Camera: Topcon TRC · optic nerve head photograph:
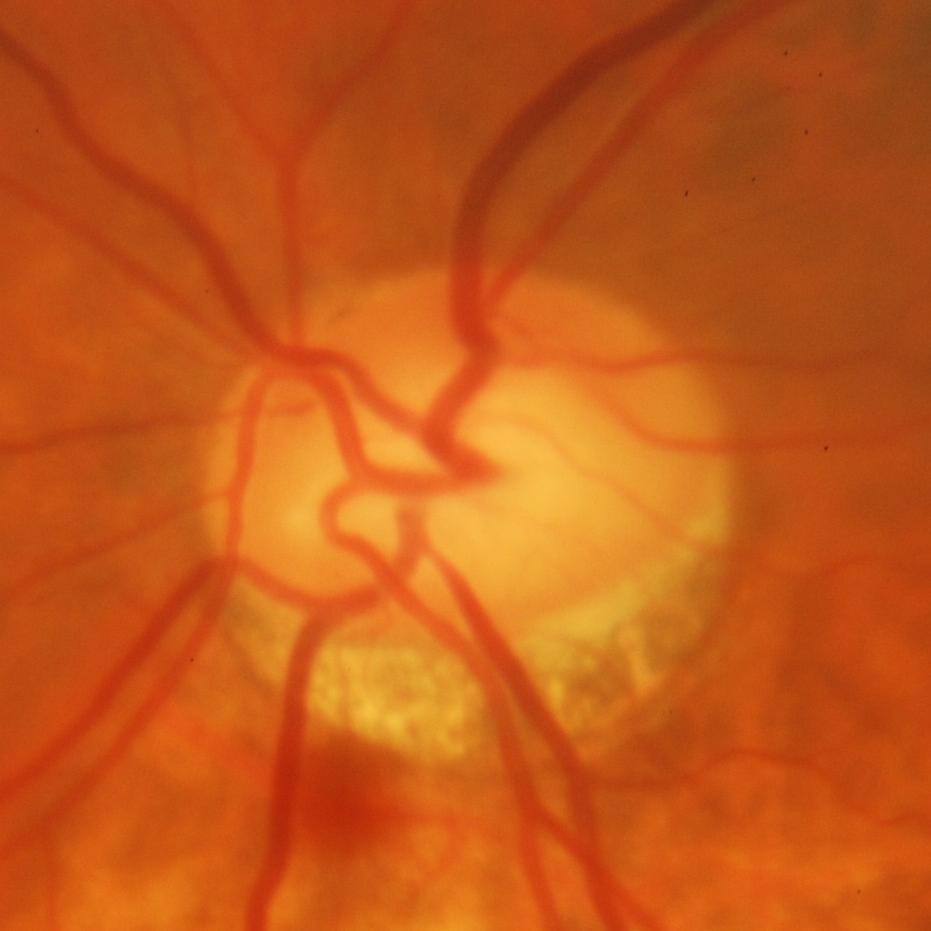 Glaucomatous changes are present.
Glaucomatous optic neuropathy.